2352 by 1568 pixels, 45° field of view, color fundus image — 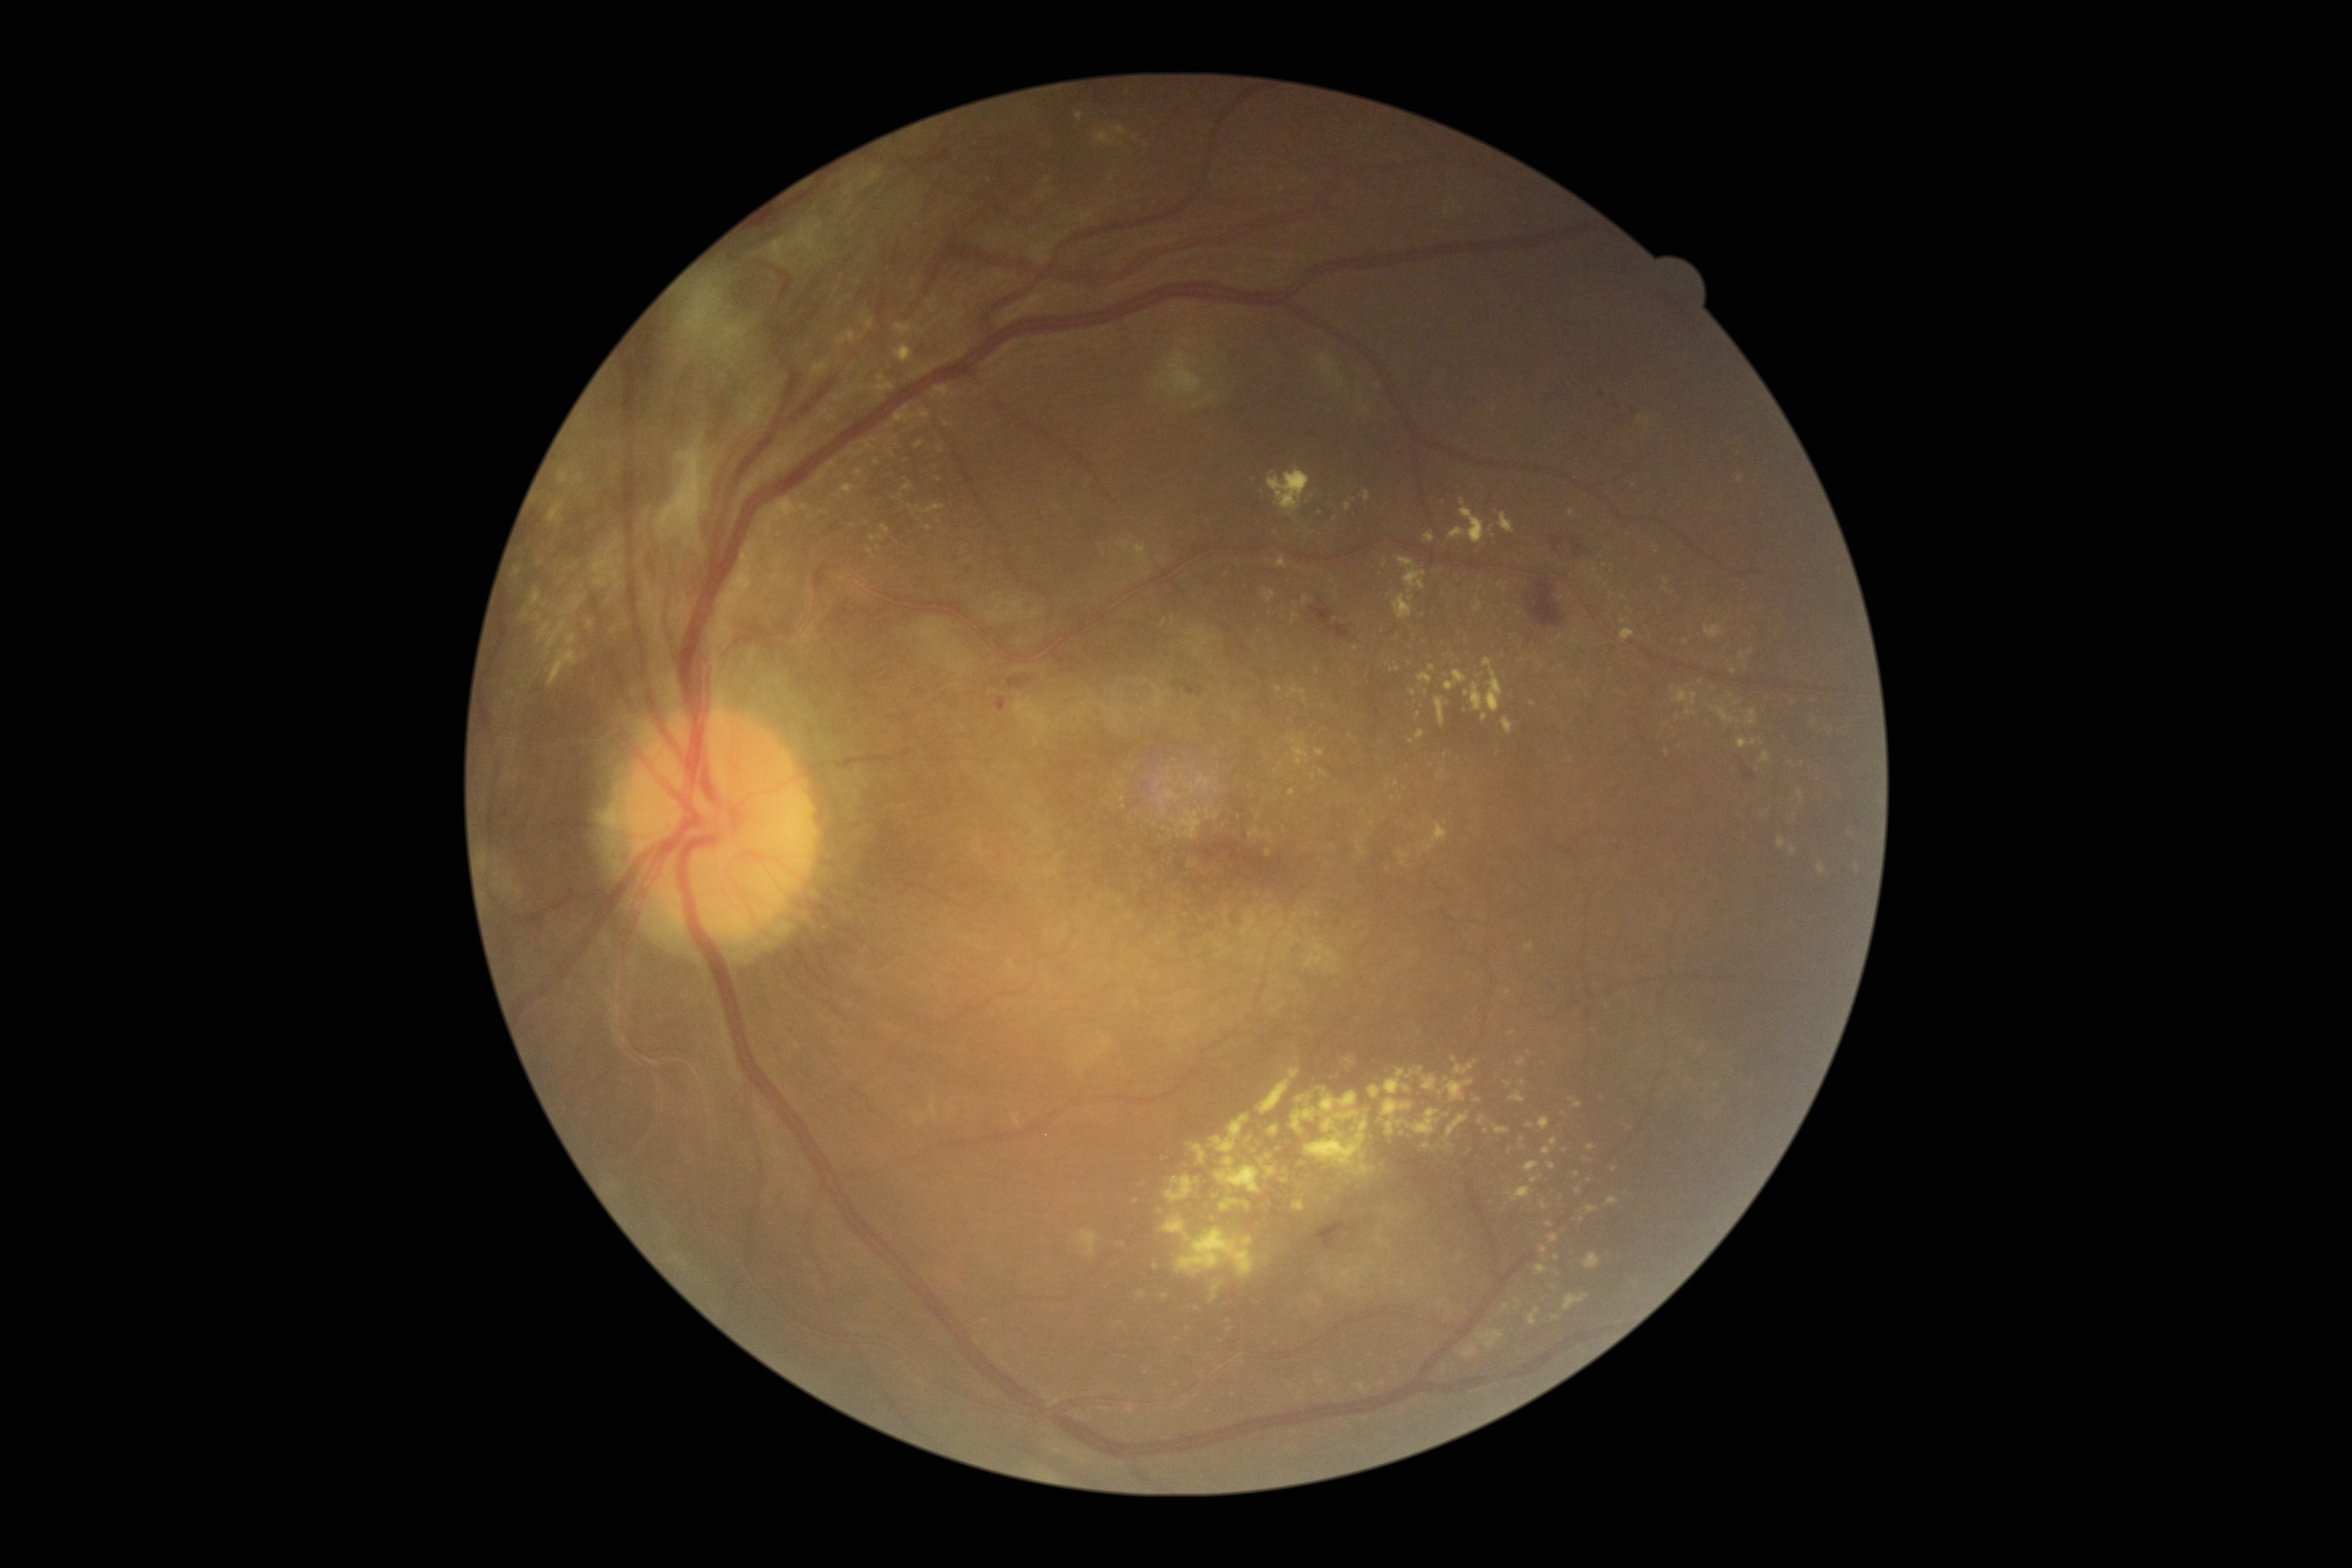 DR grade: 4 (PDR)
Lesions identified (partial list):
EXs (more not shown): {"left": 1524, "top": 1162, "right": 1540, "bottom": 1173}, {"left": 1415, "top": 729, "right": 1425, "bottom": 740}, {"left": 1322, "top": 1110, "right": 1361, "bottom": 1132}, {"left": 1288, "top": 684, "right": 1307, "bottom": 696}, {"left": 1475, "top": 1329, "right": 1503, "bottom": 1348}, {"left": 1520, "top": 1137, "right": 1526, "bottom": 1149}, {"left": 534, "top": 613, "right": 541, "bottom": 621}, {"left": 1423, "top": 531, "right": 1434, "bottom": 543}, {"left": 1503, "top": 1304, "right": 1511, "bottom": 1311}, {"left": 1267, "top": 469, "right": 1311, "bottom": 516}, {"left": 1498, "top": 512, "right": 1514, "bottom": 534}
Smaller EXs around Point(1091, 1055), Point(1445, 755), Point(1229, 1321), Point(1517, 1301), Point(1425, 693), Point(1510, 1152), Point(546, 605), Point(1624, 622)